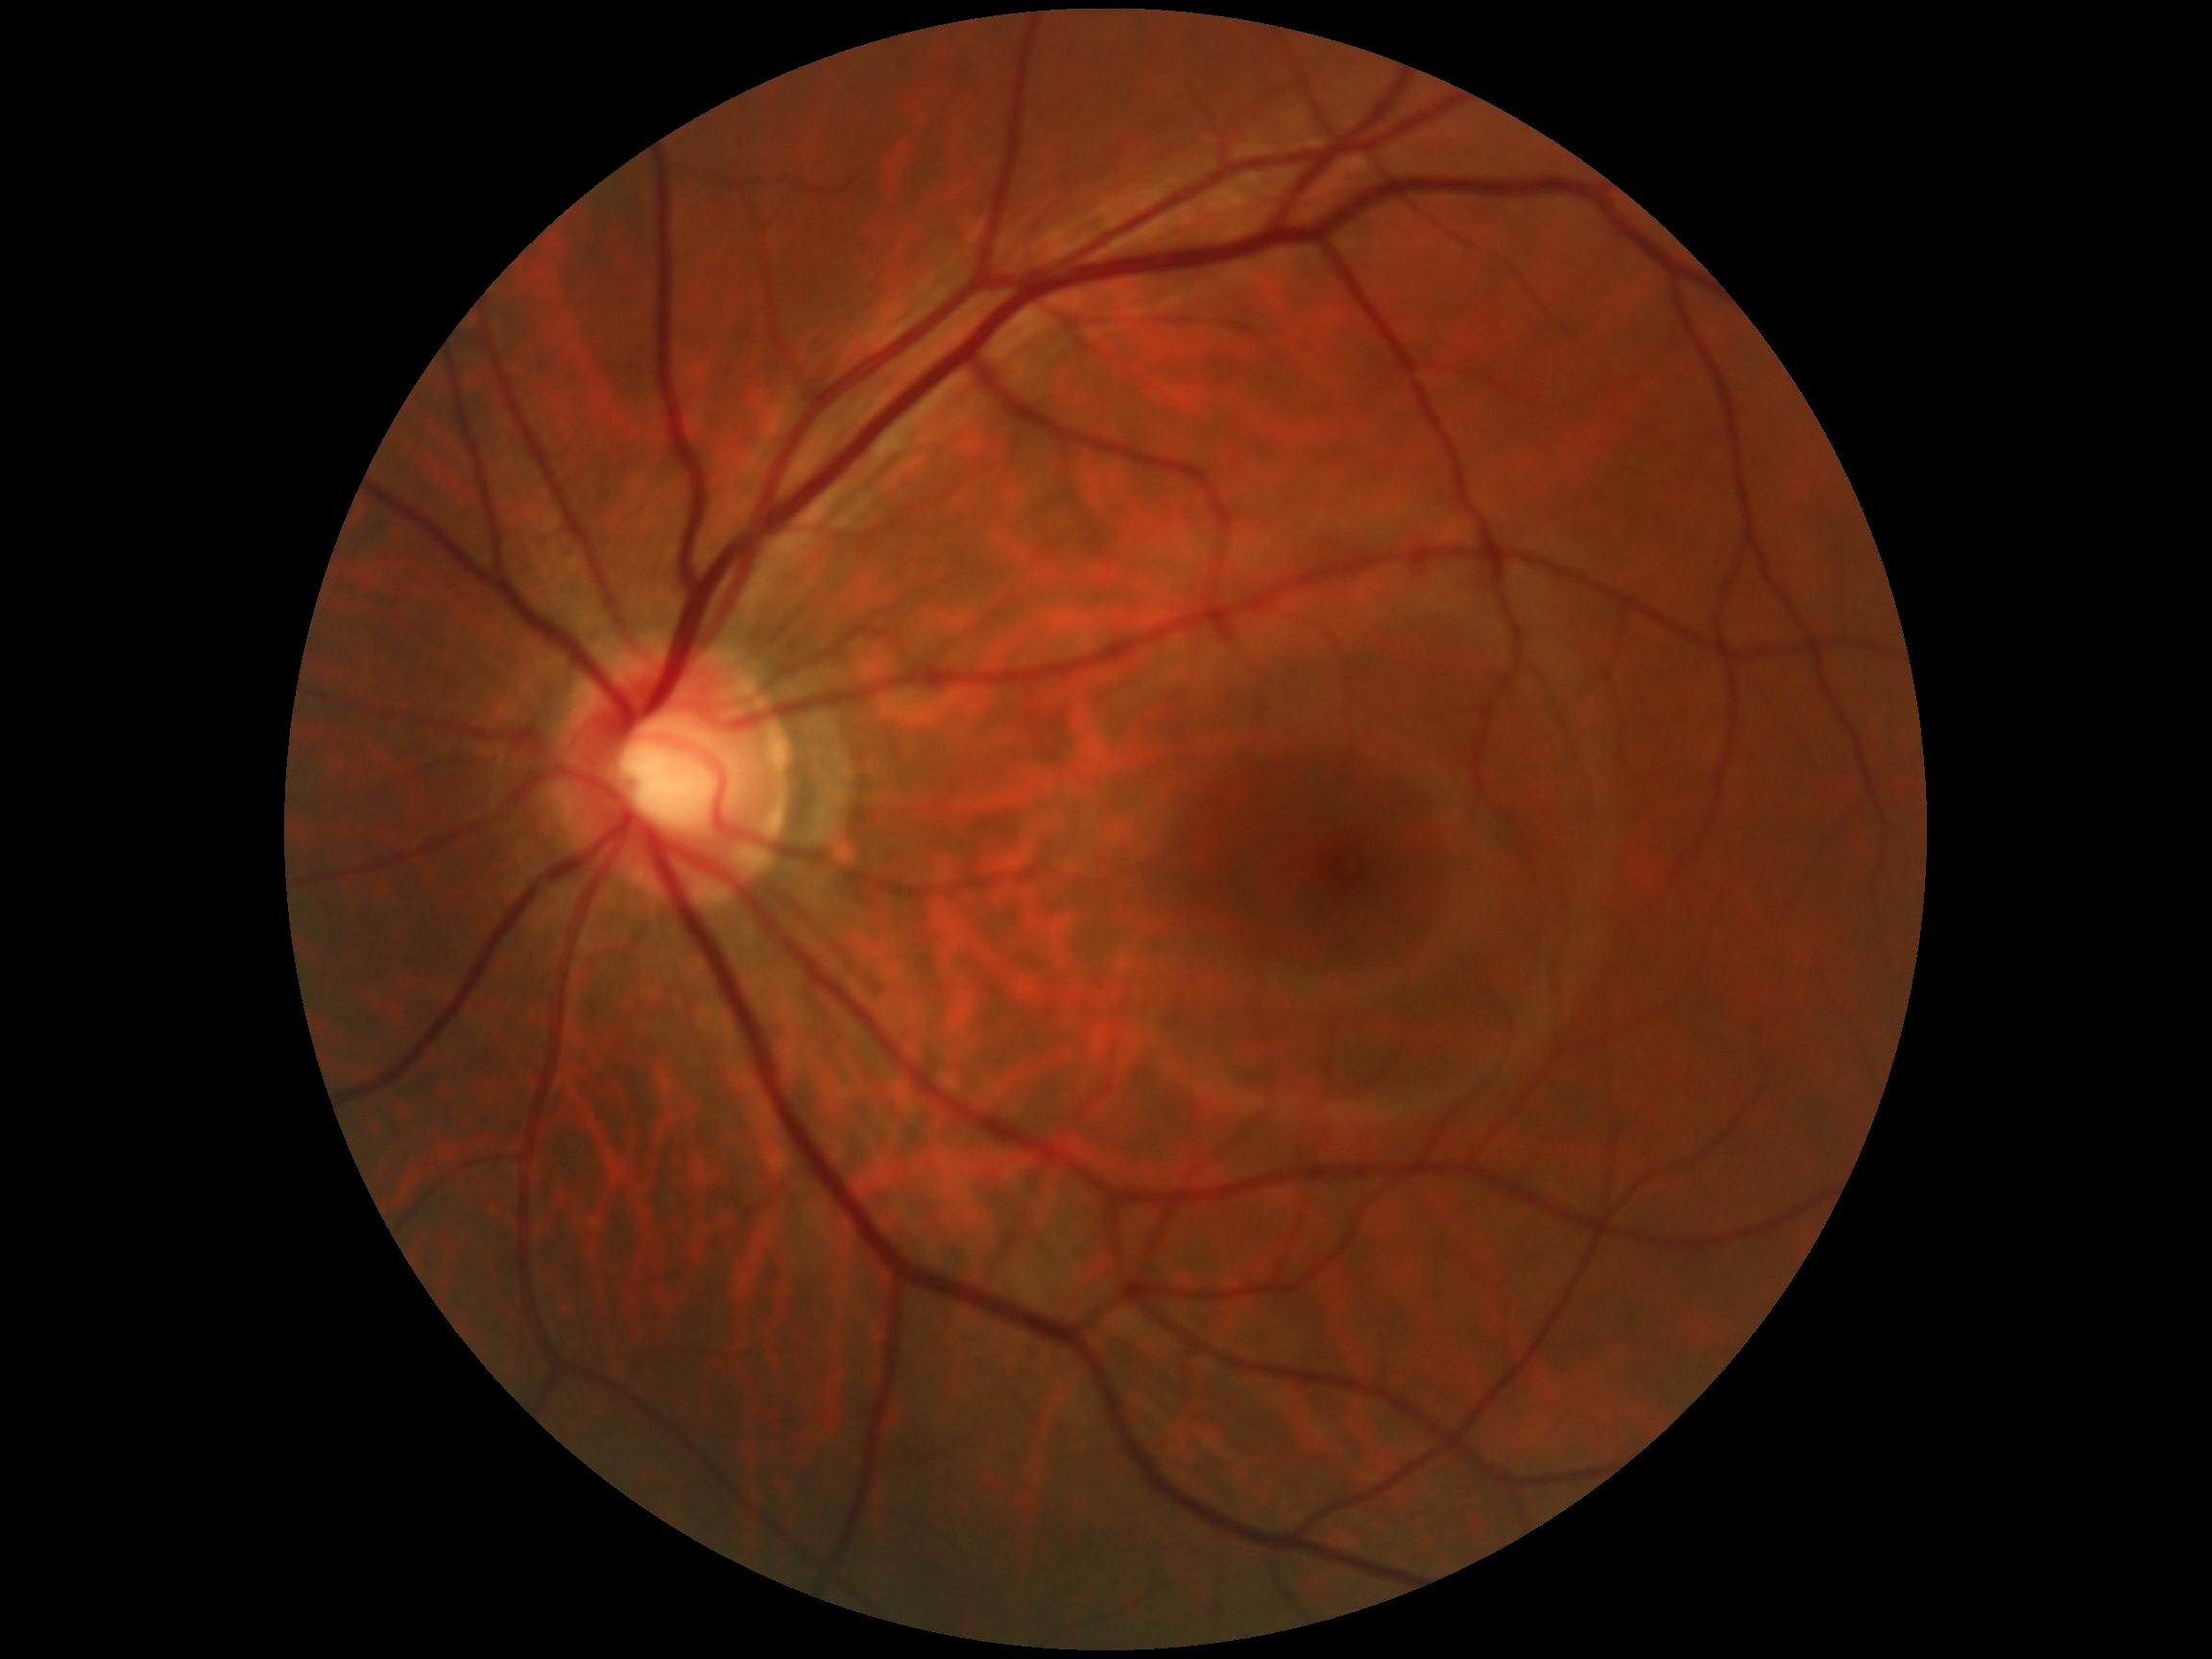
DR impression: negative for DR
retinopathy: grade 0 (no apparent retinopathy) — no visible signs of diabetic retinopathy